FOV: 45 degrees, 2352x1568, color fundus photograph:
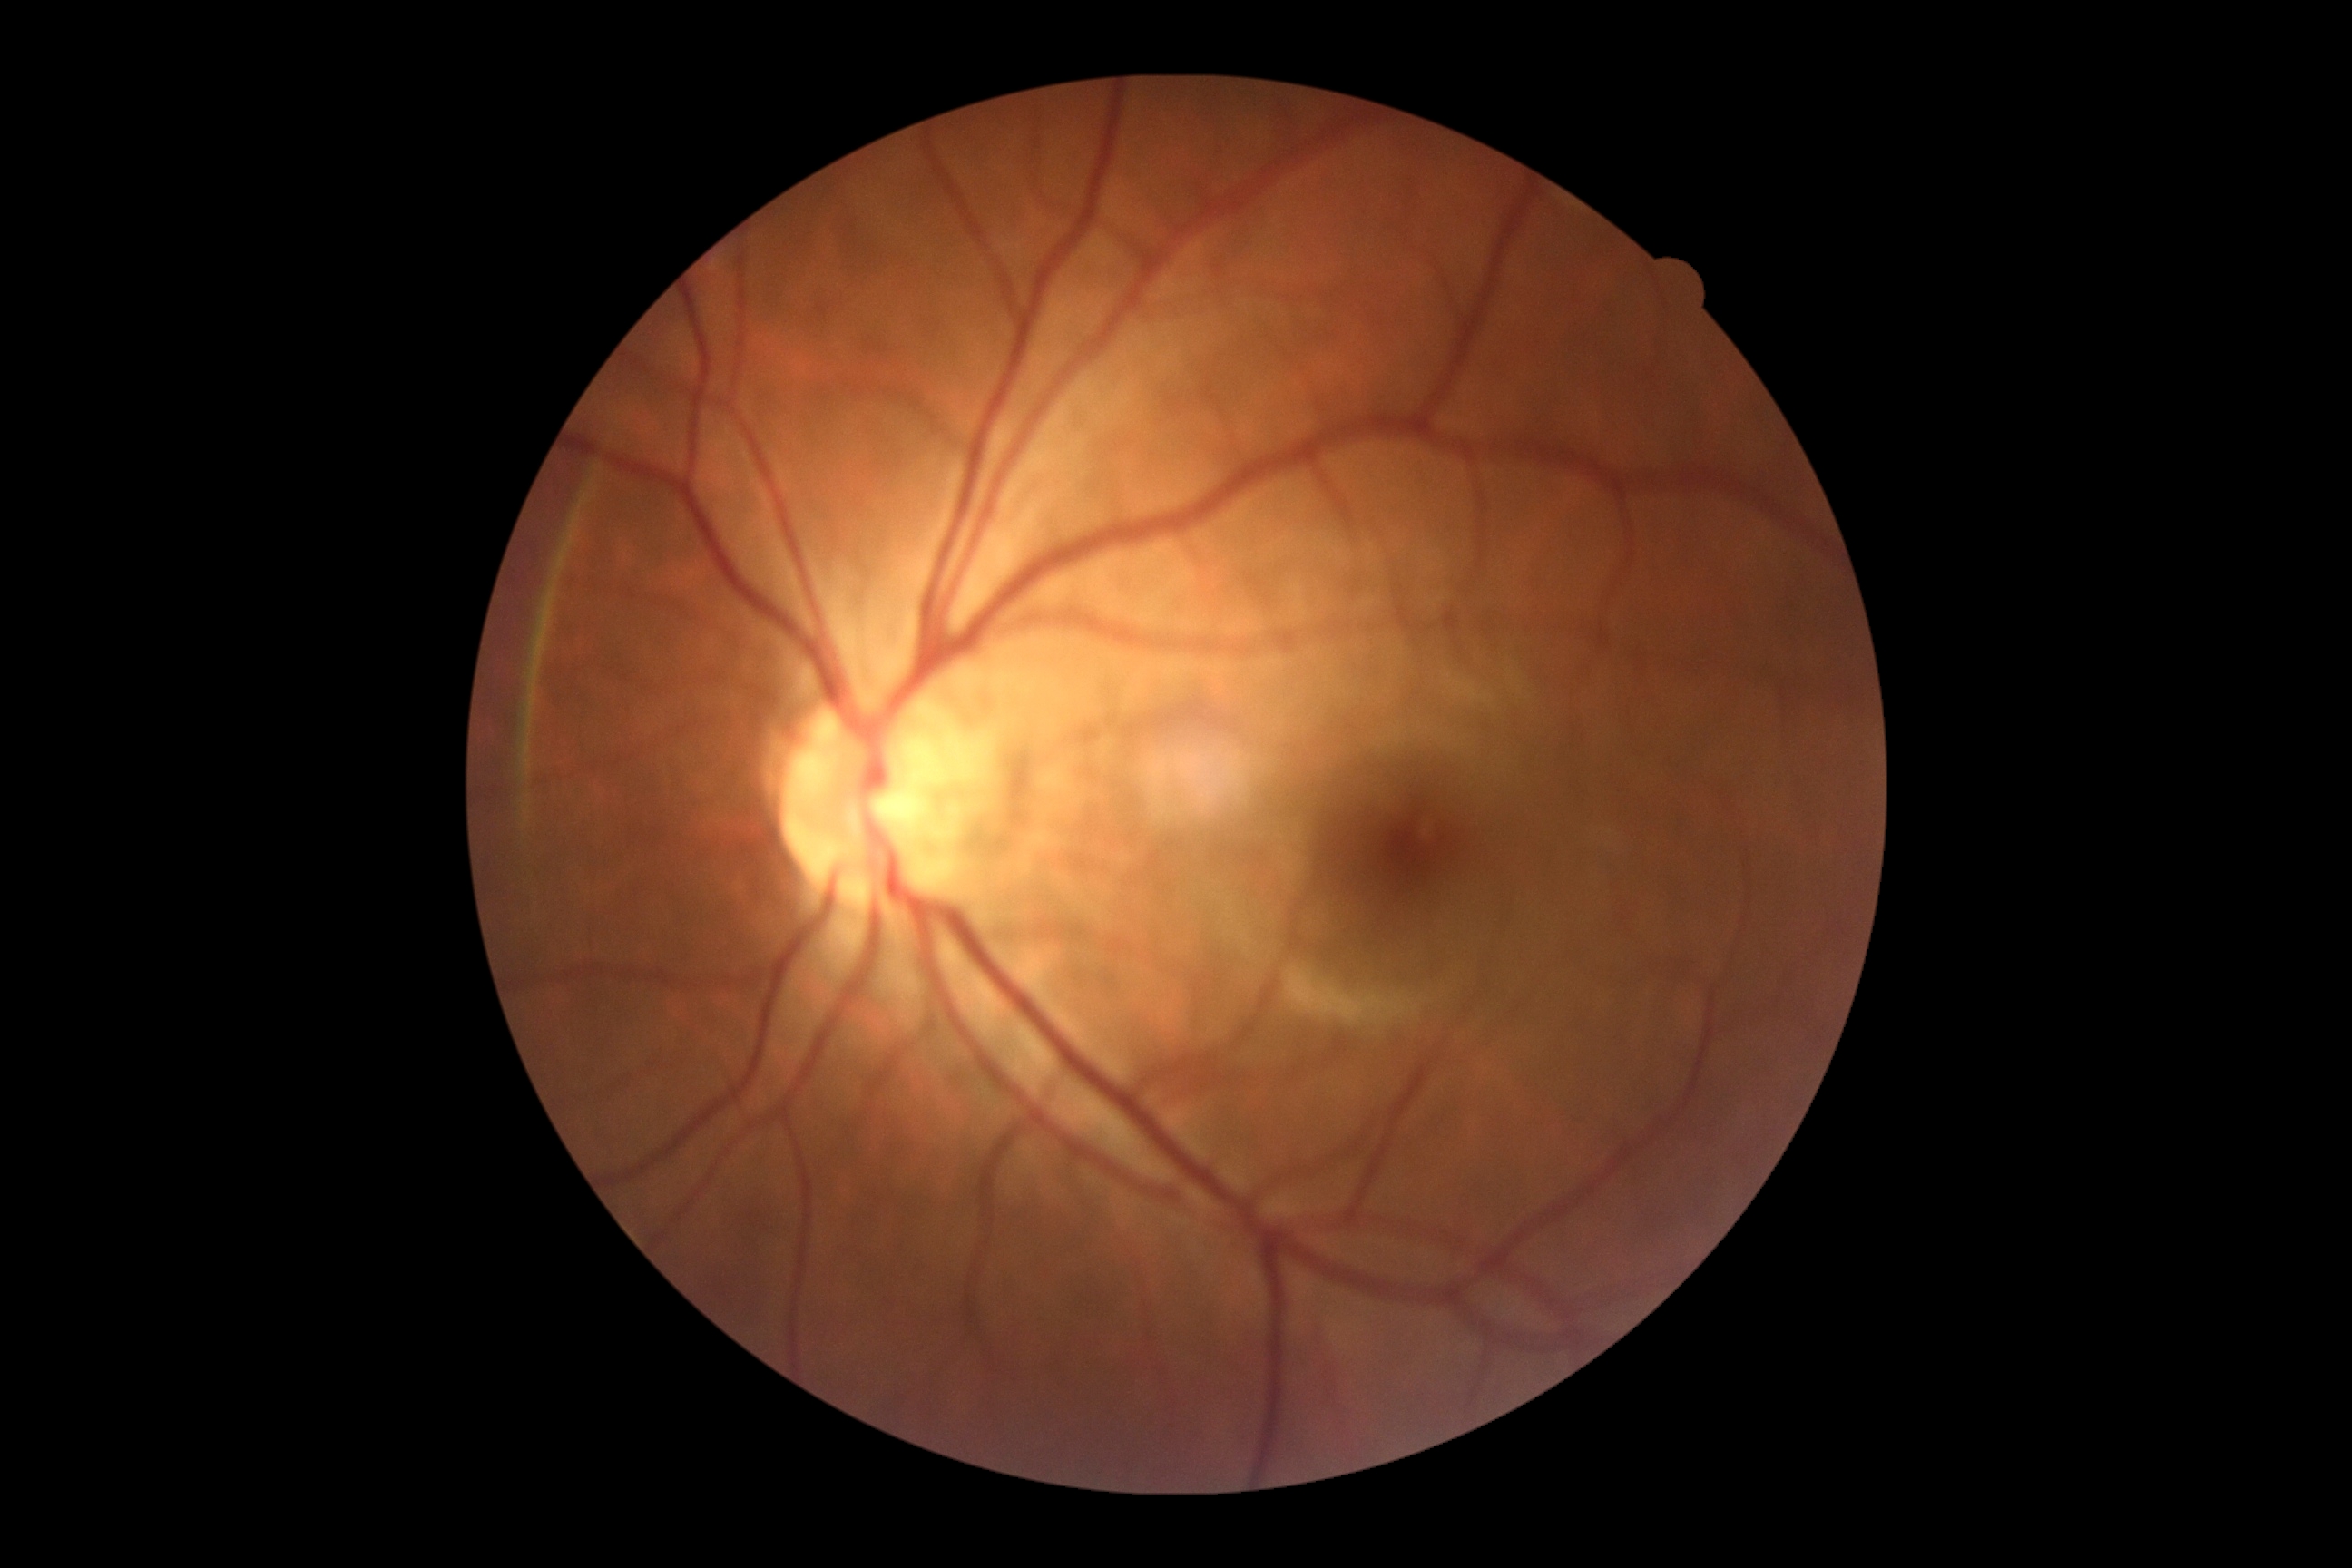

diabetic retinopathy (DR): grade 0 (no apparent retinopathy) — no visible signs of diabetic retinopathy.